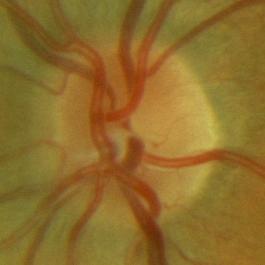
Glaucoma diagnosis = no glaucomatous damage.